Color fundus photograph. DR severity per modified Davis staging. 45° FOV
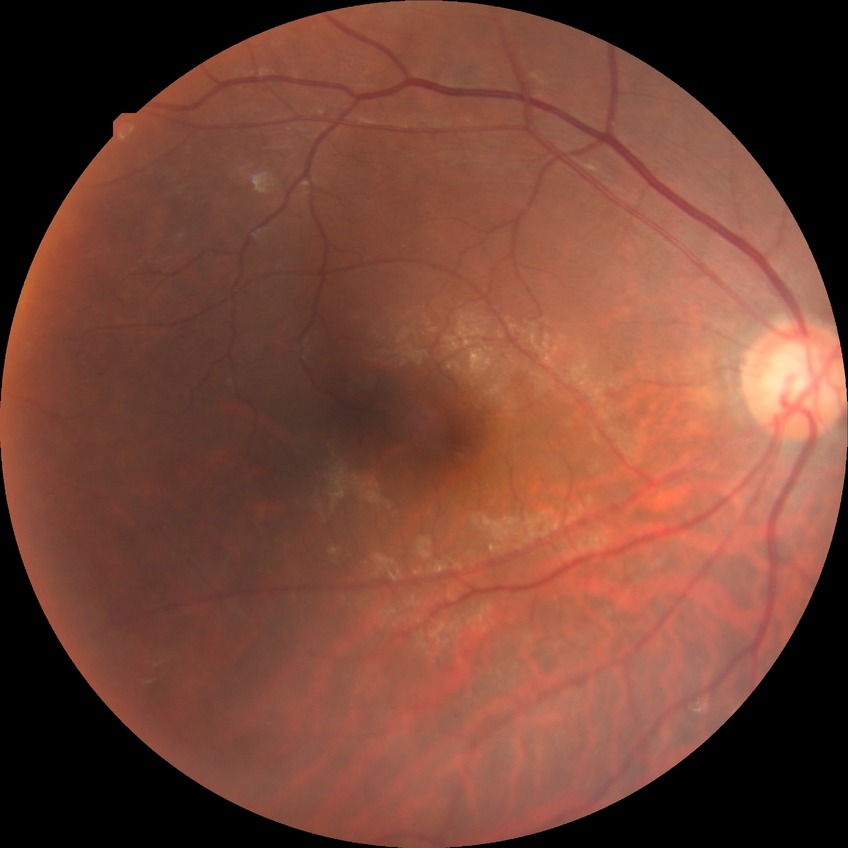 diabetic retinopathy (DR) = simple diabetic retinopathy (SDR)